2212 x 1659 pixels — 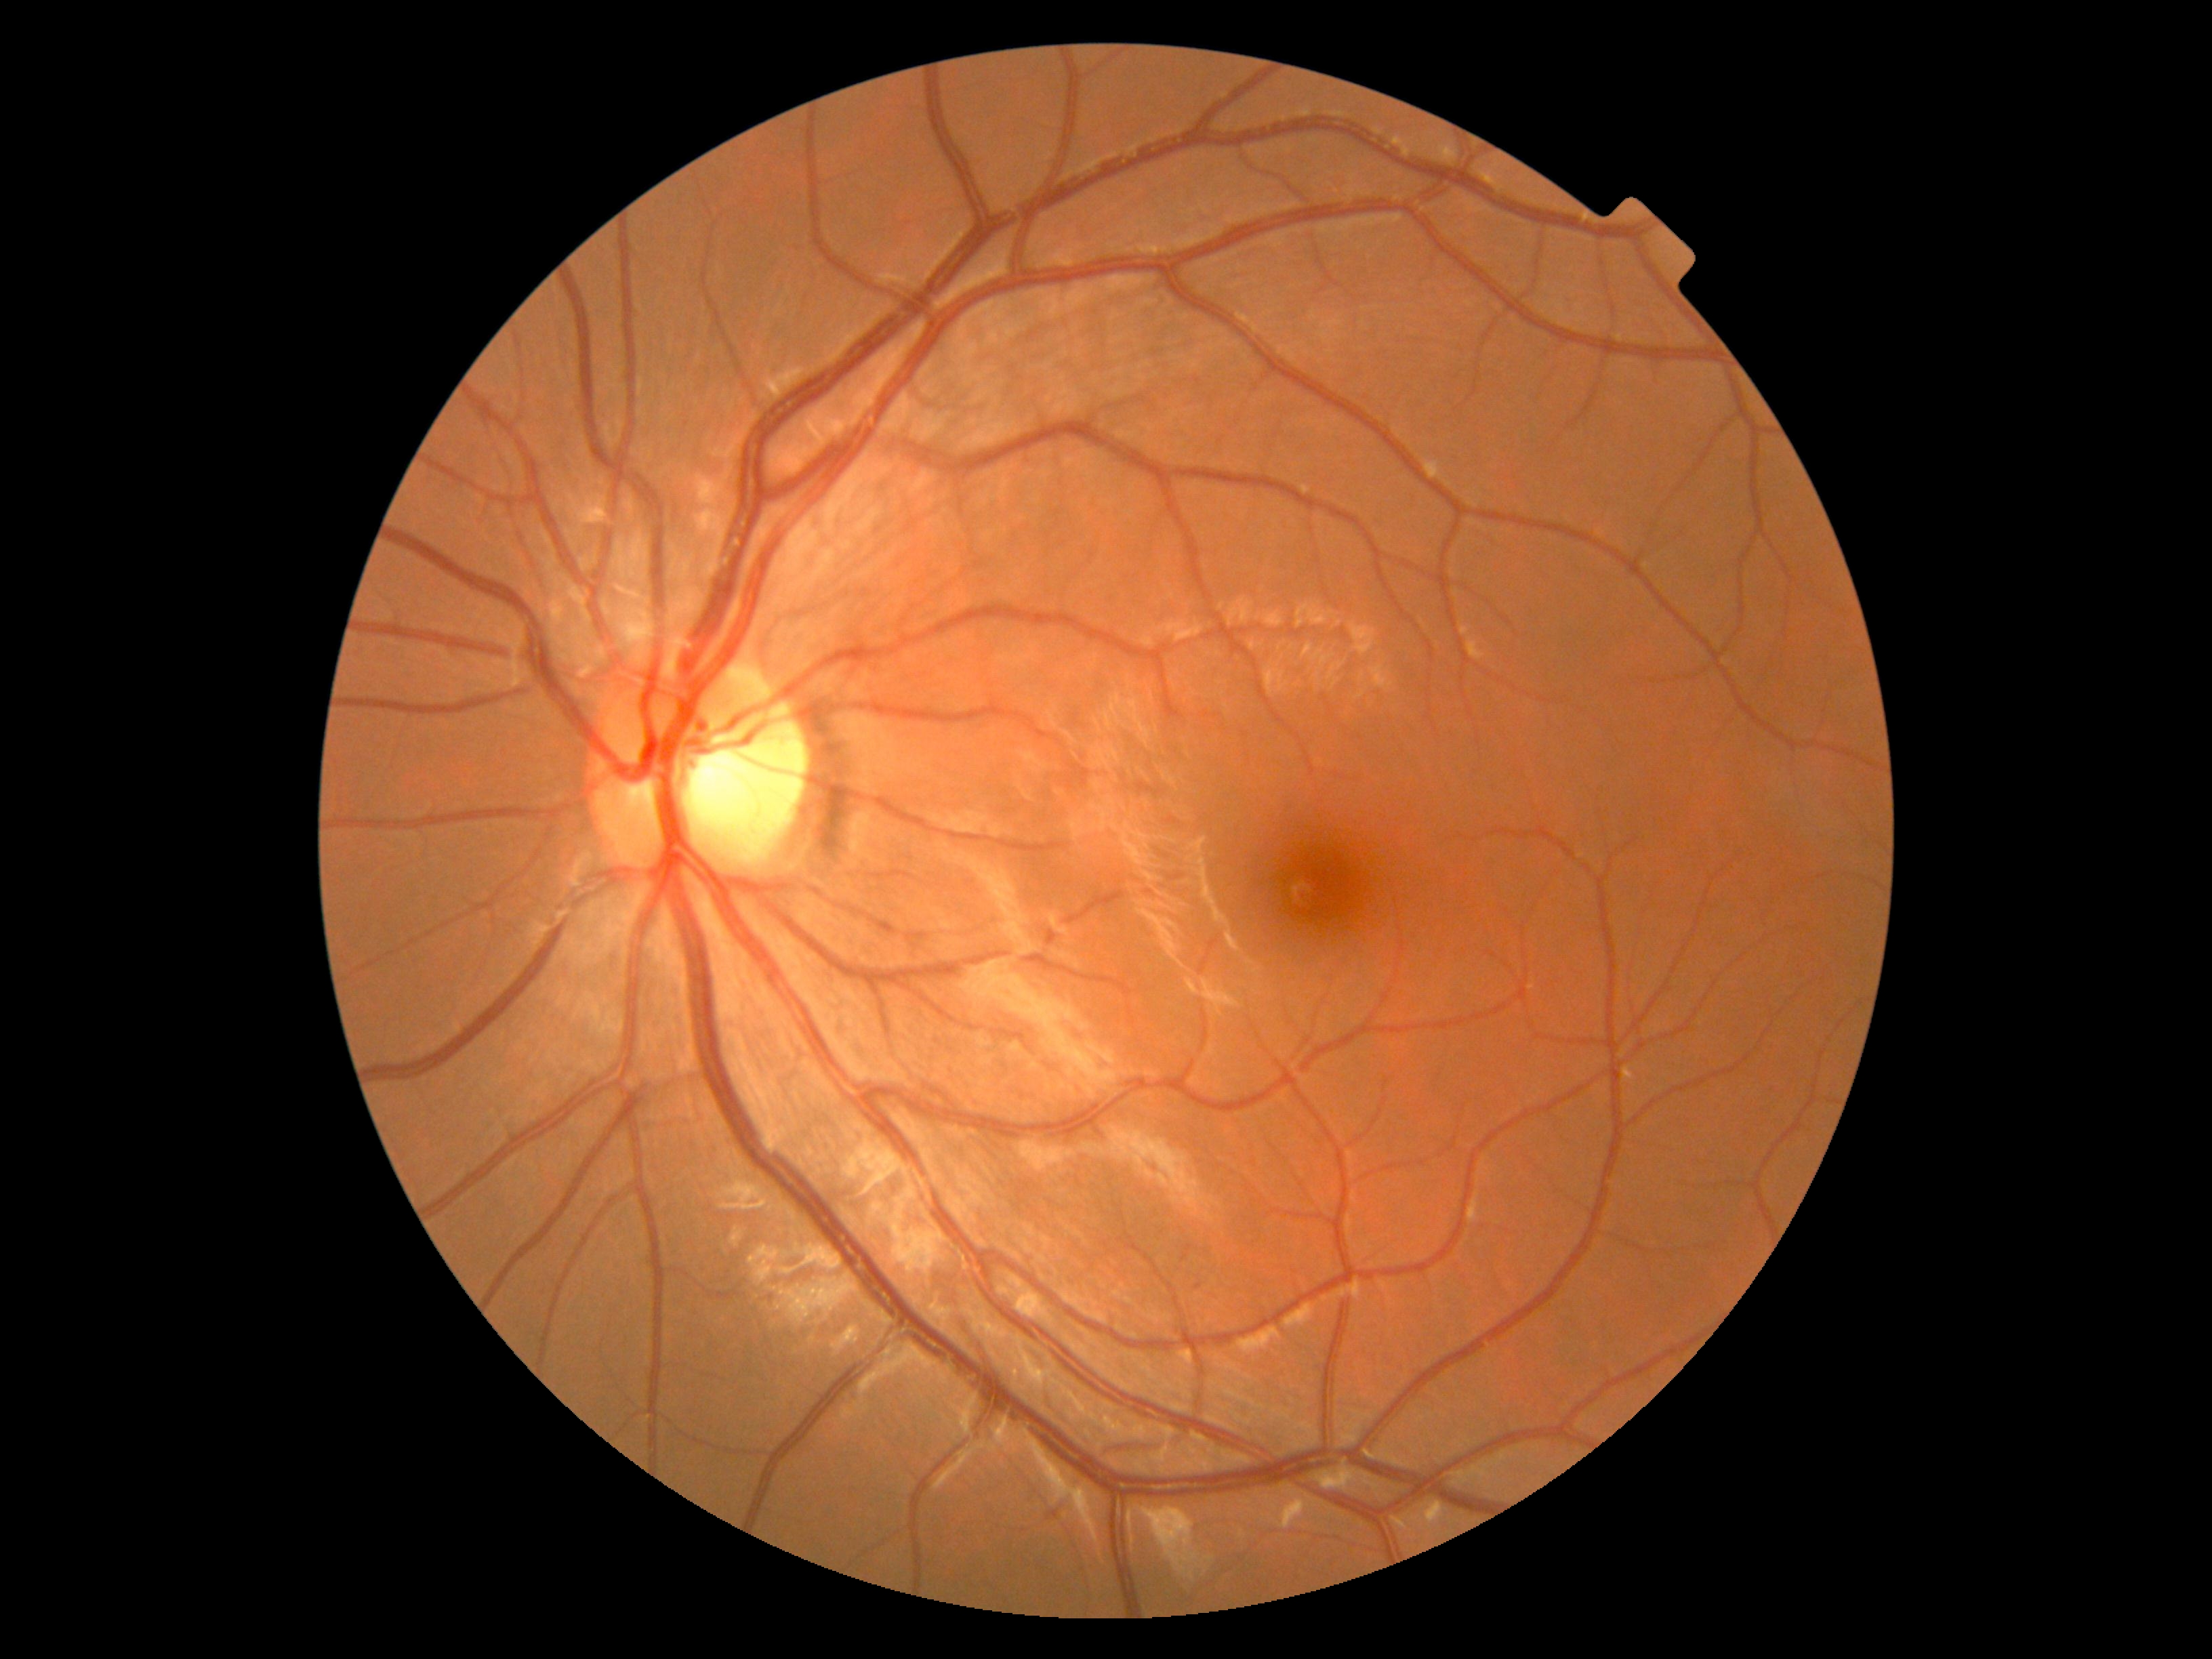 DR severity: no apparent diabetic retinopathy (grade 0).